Retinal fundus photograph.
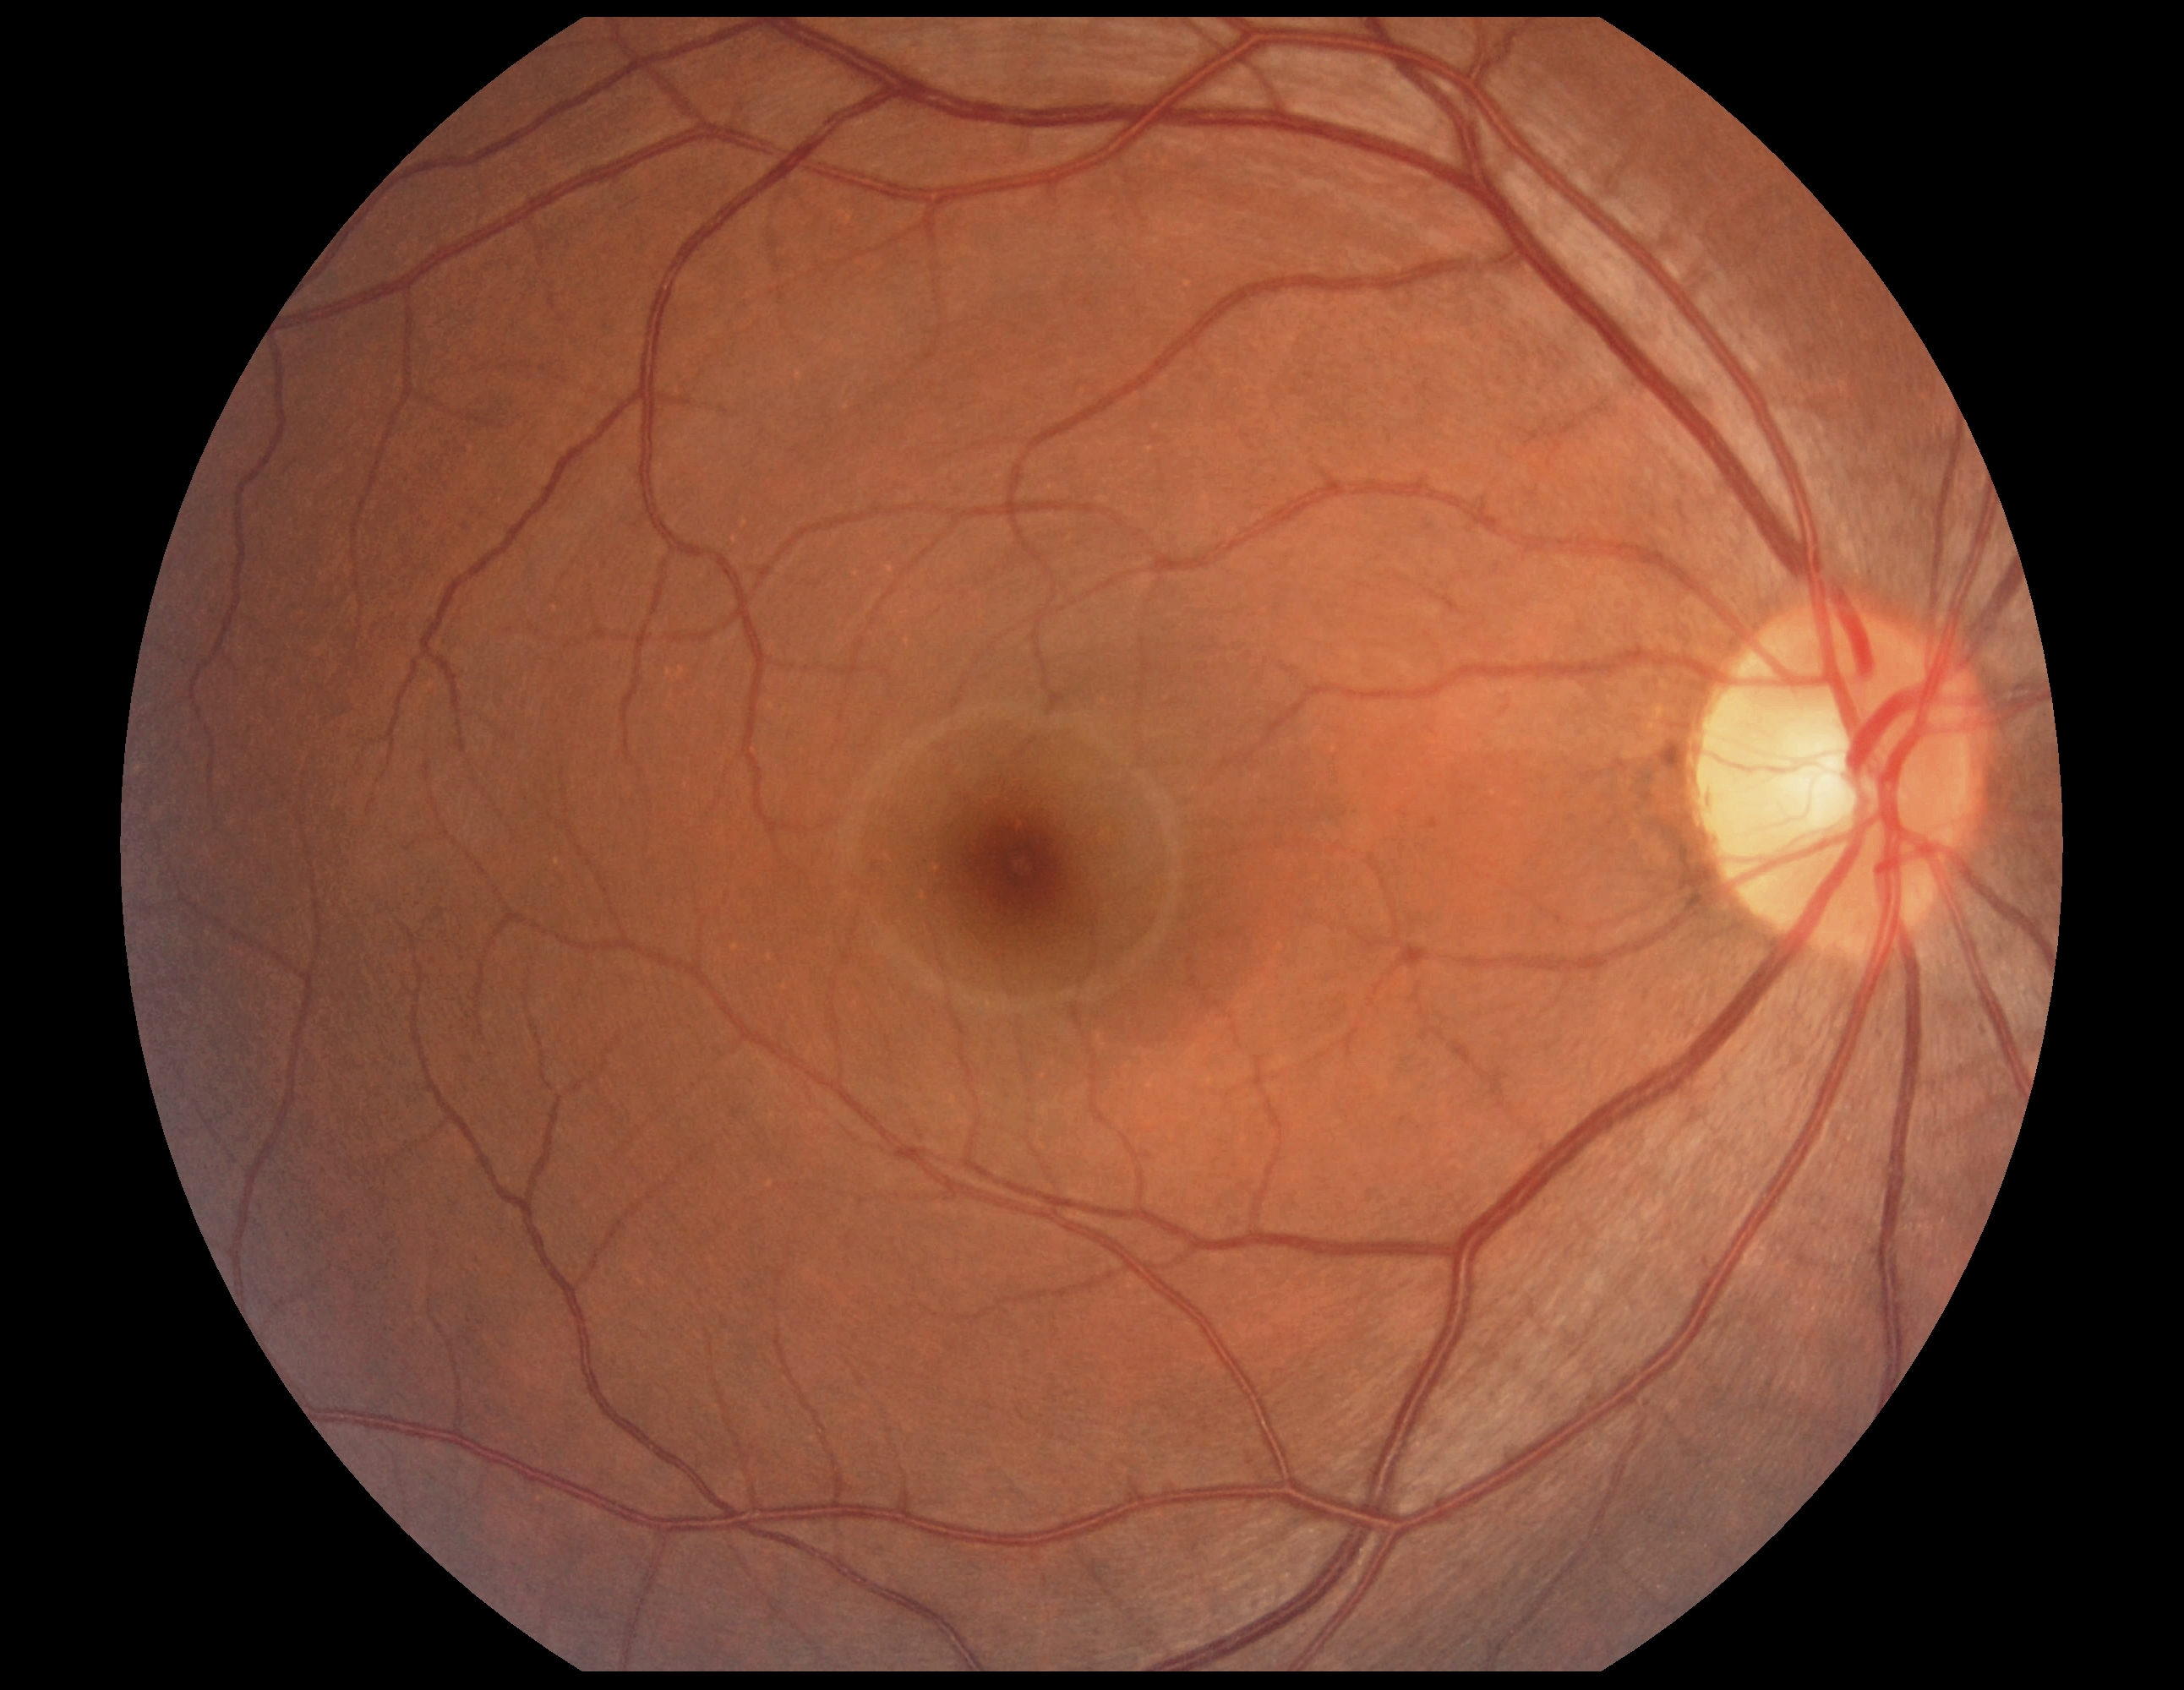

No signs of diabetic retinopathy. Diabetic retinopathy grade is 0 (no apparent retinopathy).